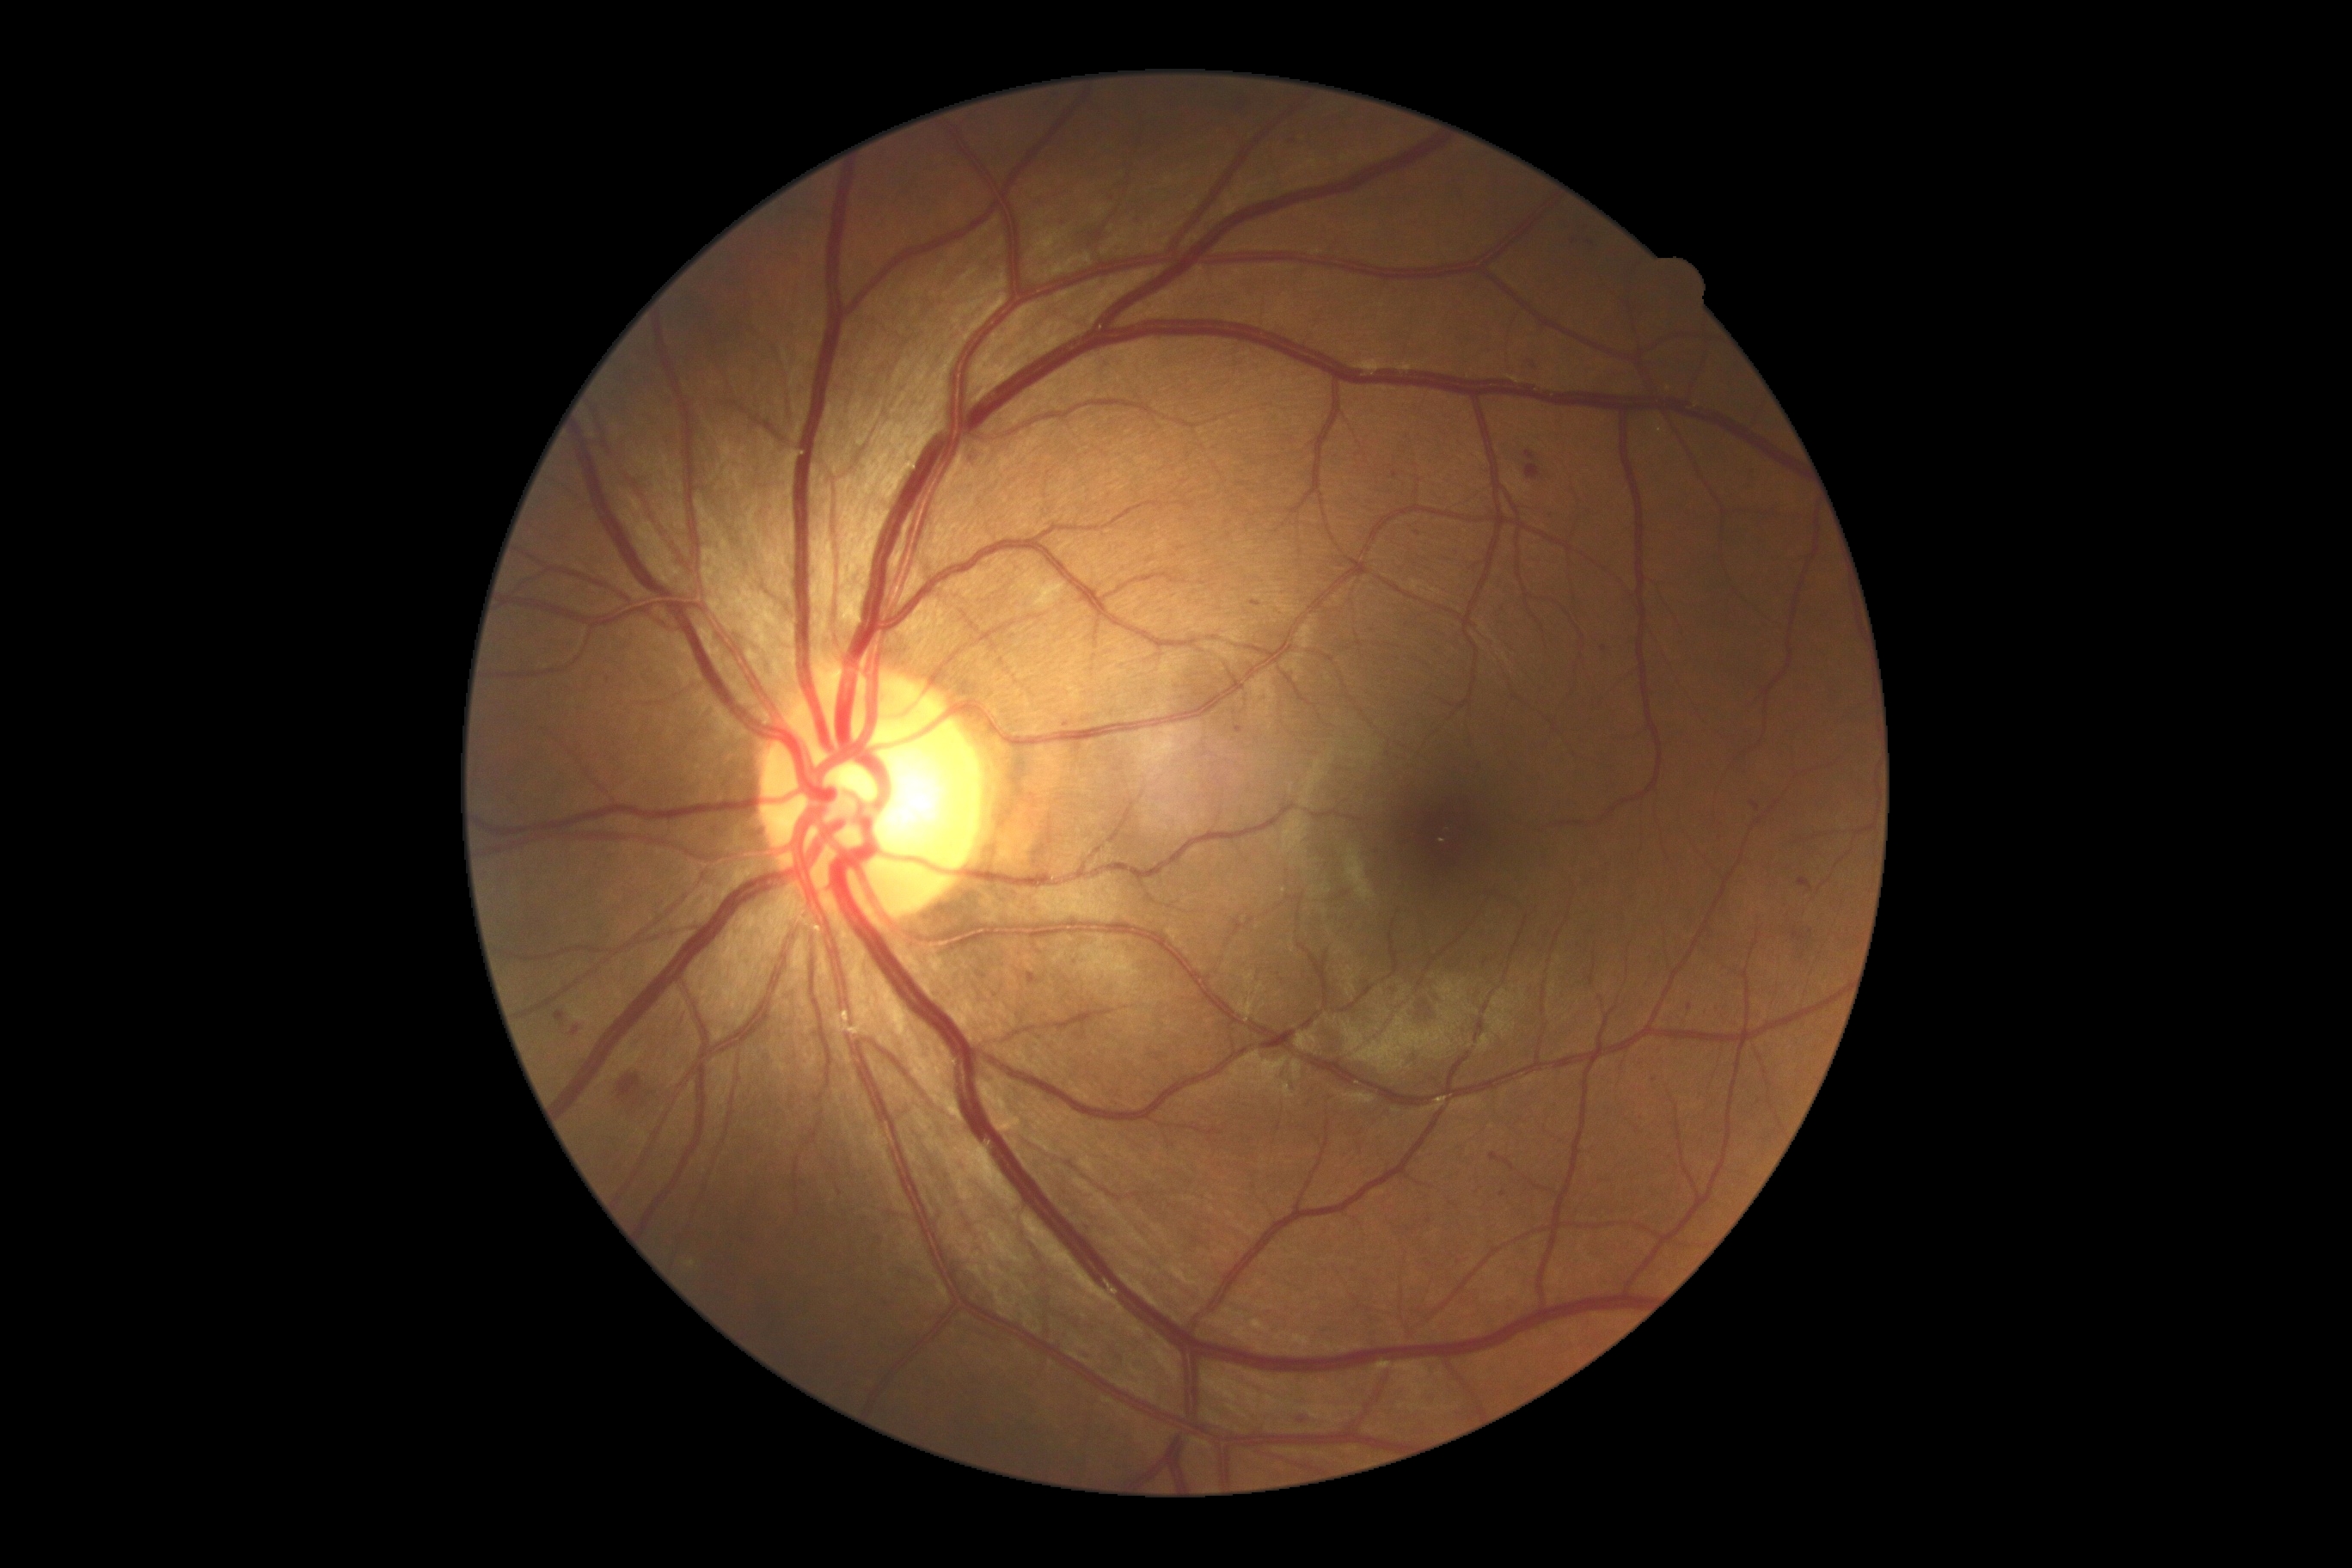

Retinopathy: 2
Representative lesions:
microaneurysms (subset): 1528, 362, 1545, 377; 1751, 802, 1761, 812; 572, 1027, 579, 1038; 554, 1012, 565, 1022; 1799, 878, 1813, 893; 1253, 601, 1261, 608
Smaller microaneurysms around (1590; 243); (1604; 649); (1691; 1008); (1395; 475); (1655; 1080)
soft exudates: absent
hard exudates: absent
hemorrhages: 634, 1098, 642, 1106; 618, 1075, 640, 1099; 1792, 928, 1810, 945; 1801, 950, 1806, 959
Smaller hemorrhages around (1811; 931)